Modified Davis classification. FOV: 45 degrees — 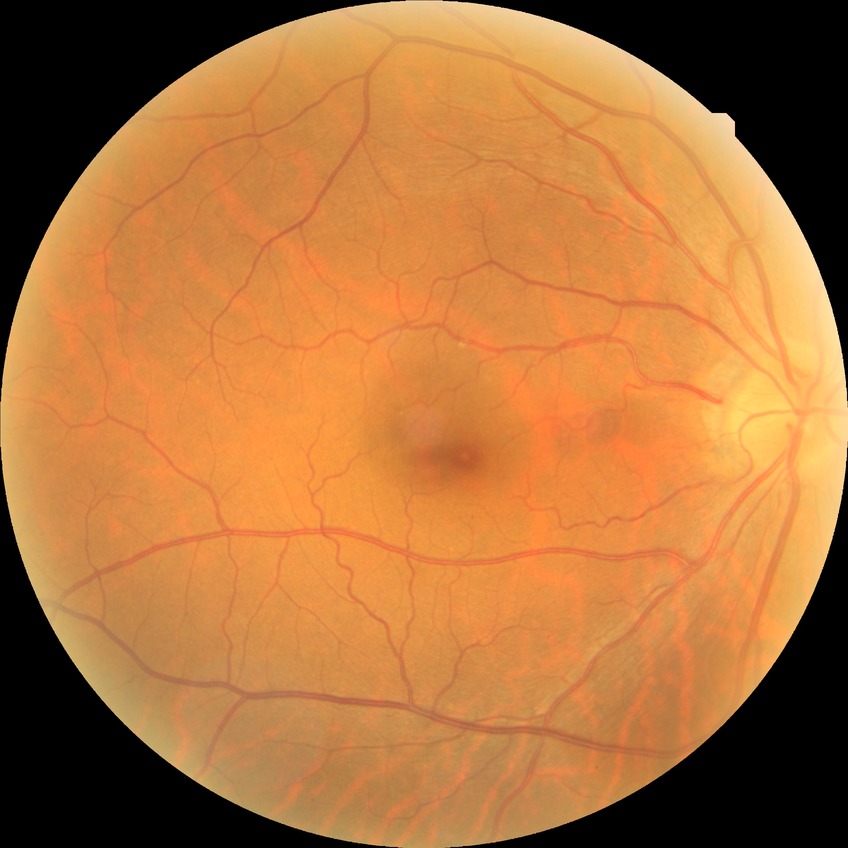 * diabetic retinopathy (DR): NDR (no diabetic retinopathy)